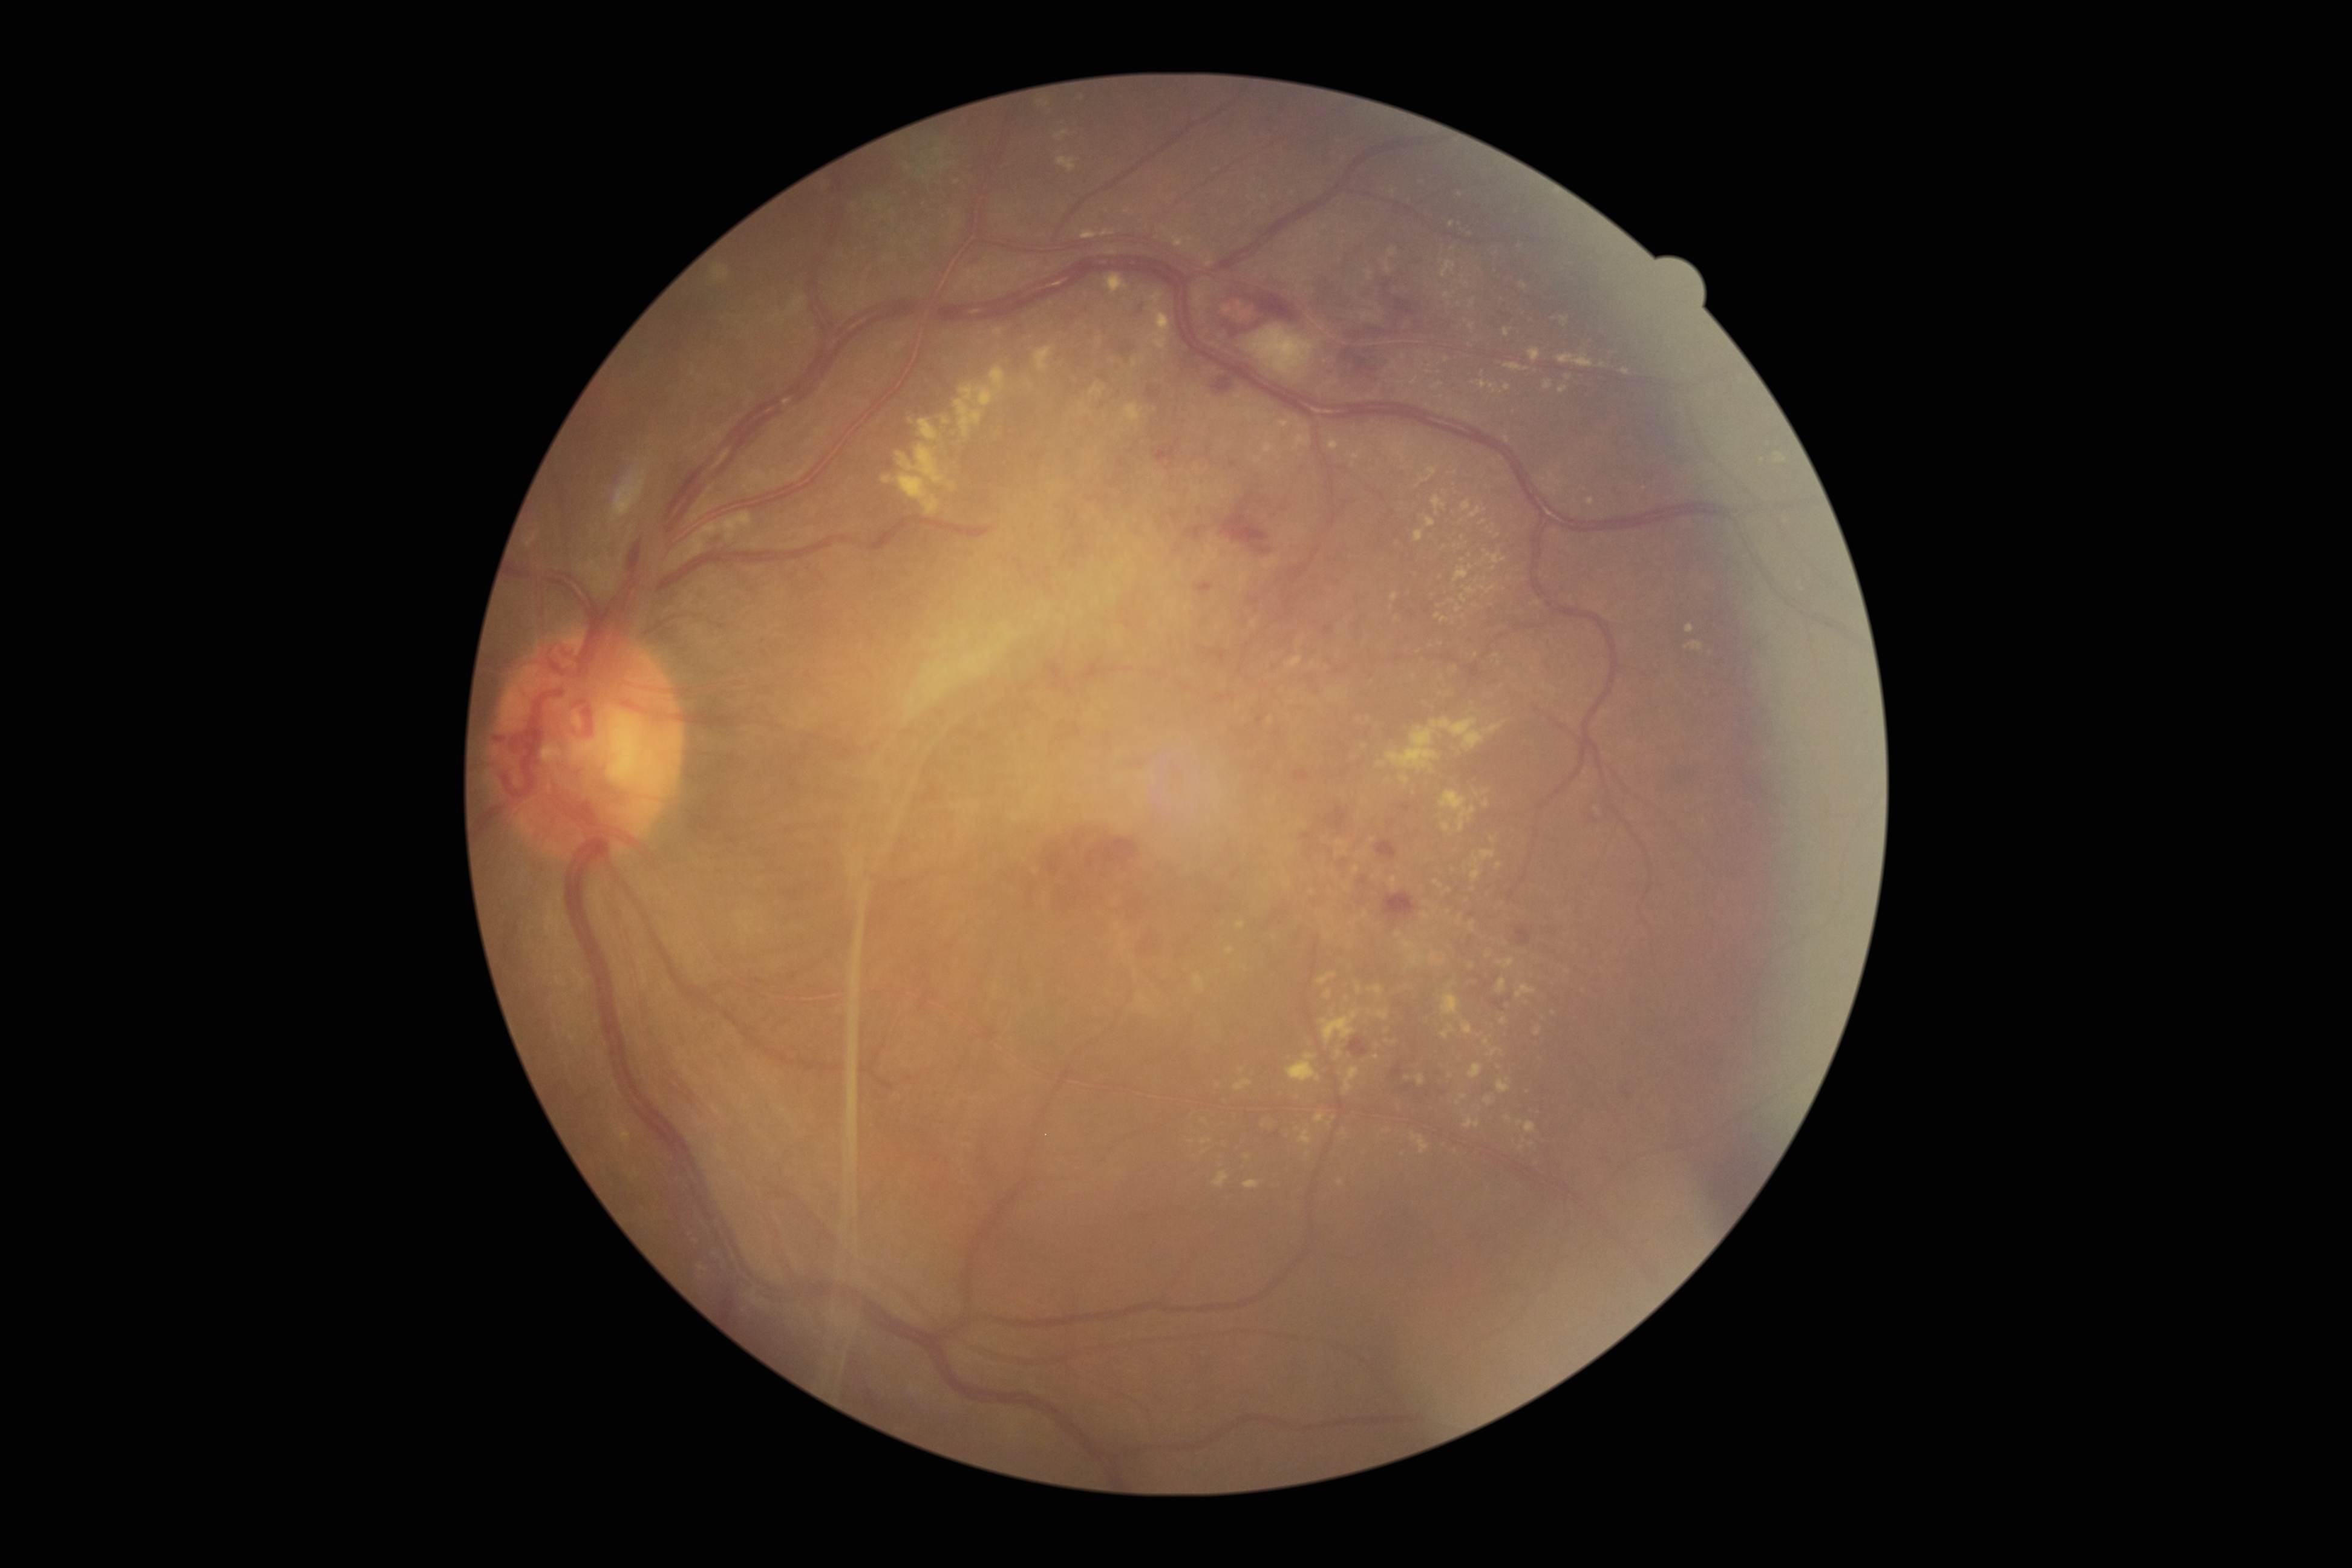
{"partial":true,"dr_grade":4,"lesions":{"ex":[[1392,439,1409,463],[1686,641,1704,650],[1325,990,1331,999],[1368,987,1383,995],[1501,1017,1508,1025],[1461,500,1471,511],[1486,552,1507,564],[1237,921,1246,930],[1439,792,1477,832],[1400,776,1410,785],[1440,1025,1456,1039]],"ex_small_centers":[[1477,794],[1371,398],[1460,195],[1455,669],[1386,1031],[1270,720],[1333,873],[945,168],[1463,276]]}}